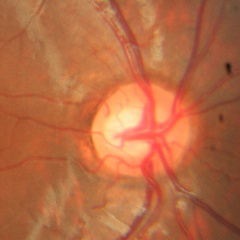

Q: What is the glaucoma diagnosis?
A: No evidence of glaucoma.